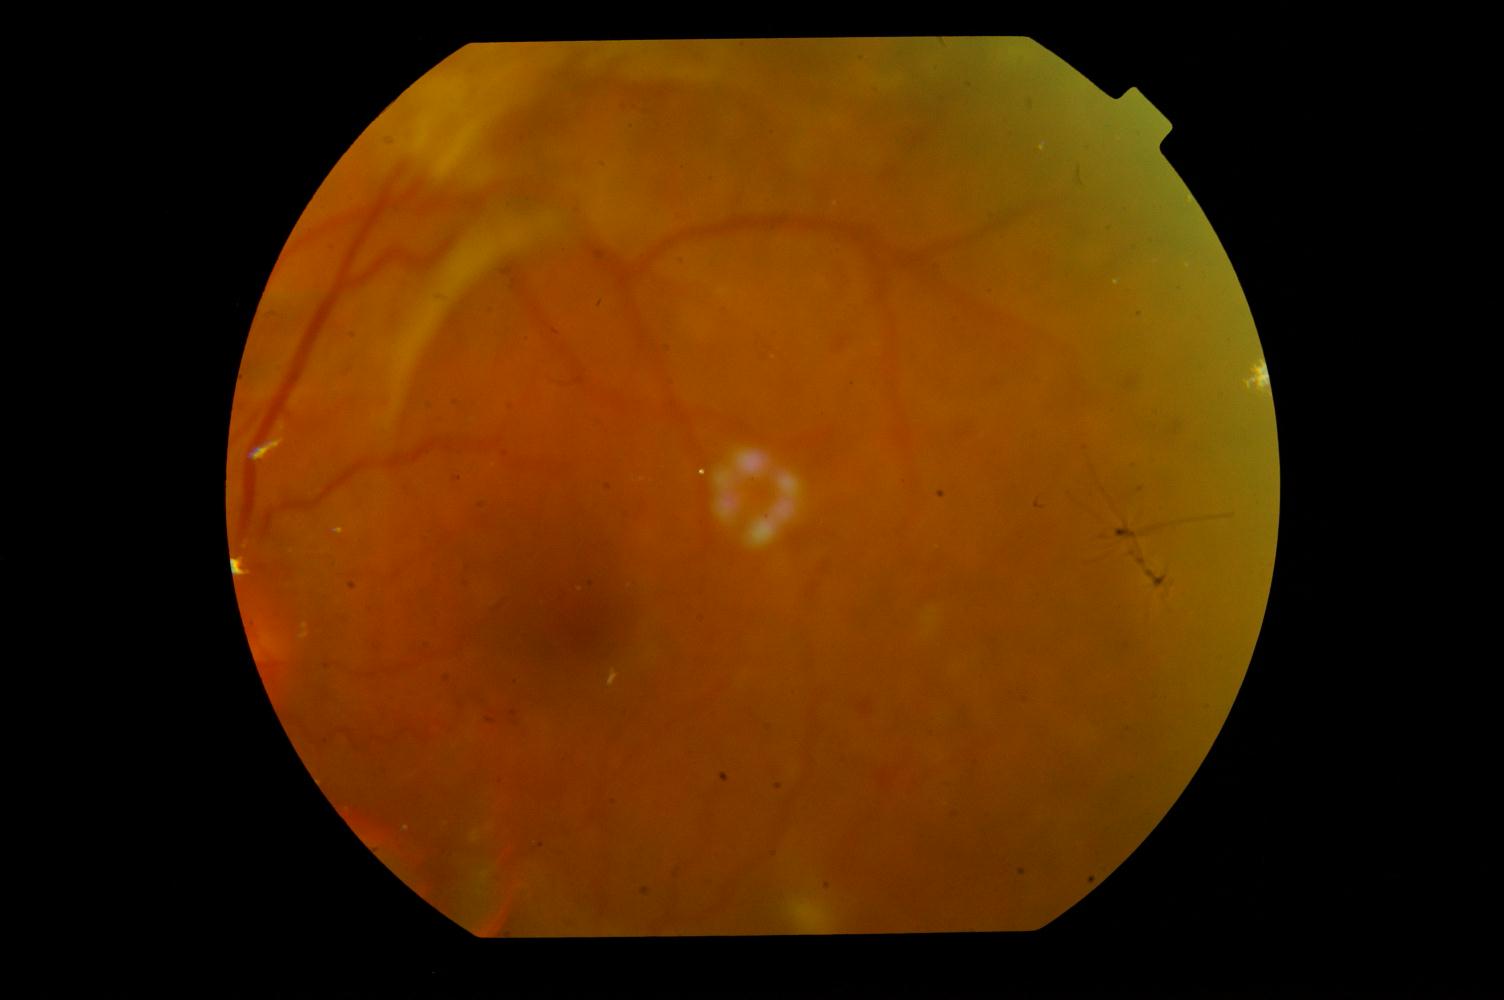

There is evidence of diabetic retinopathy.